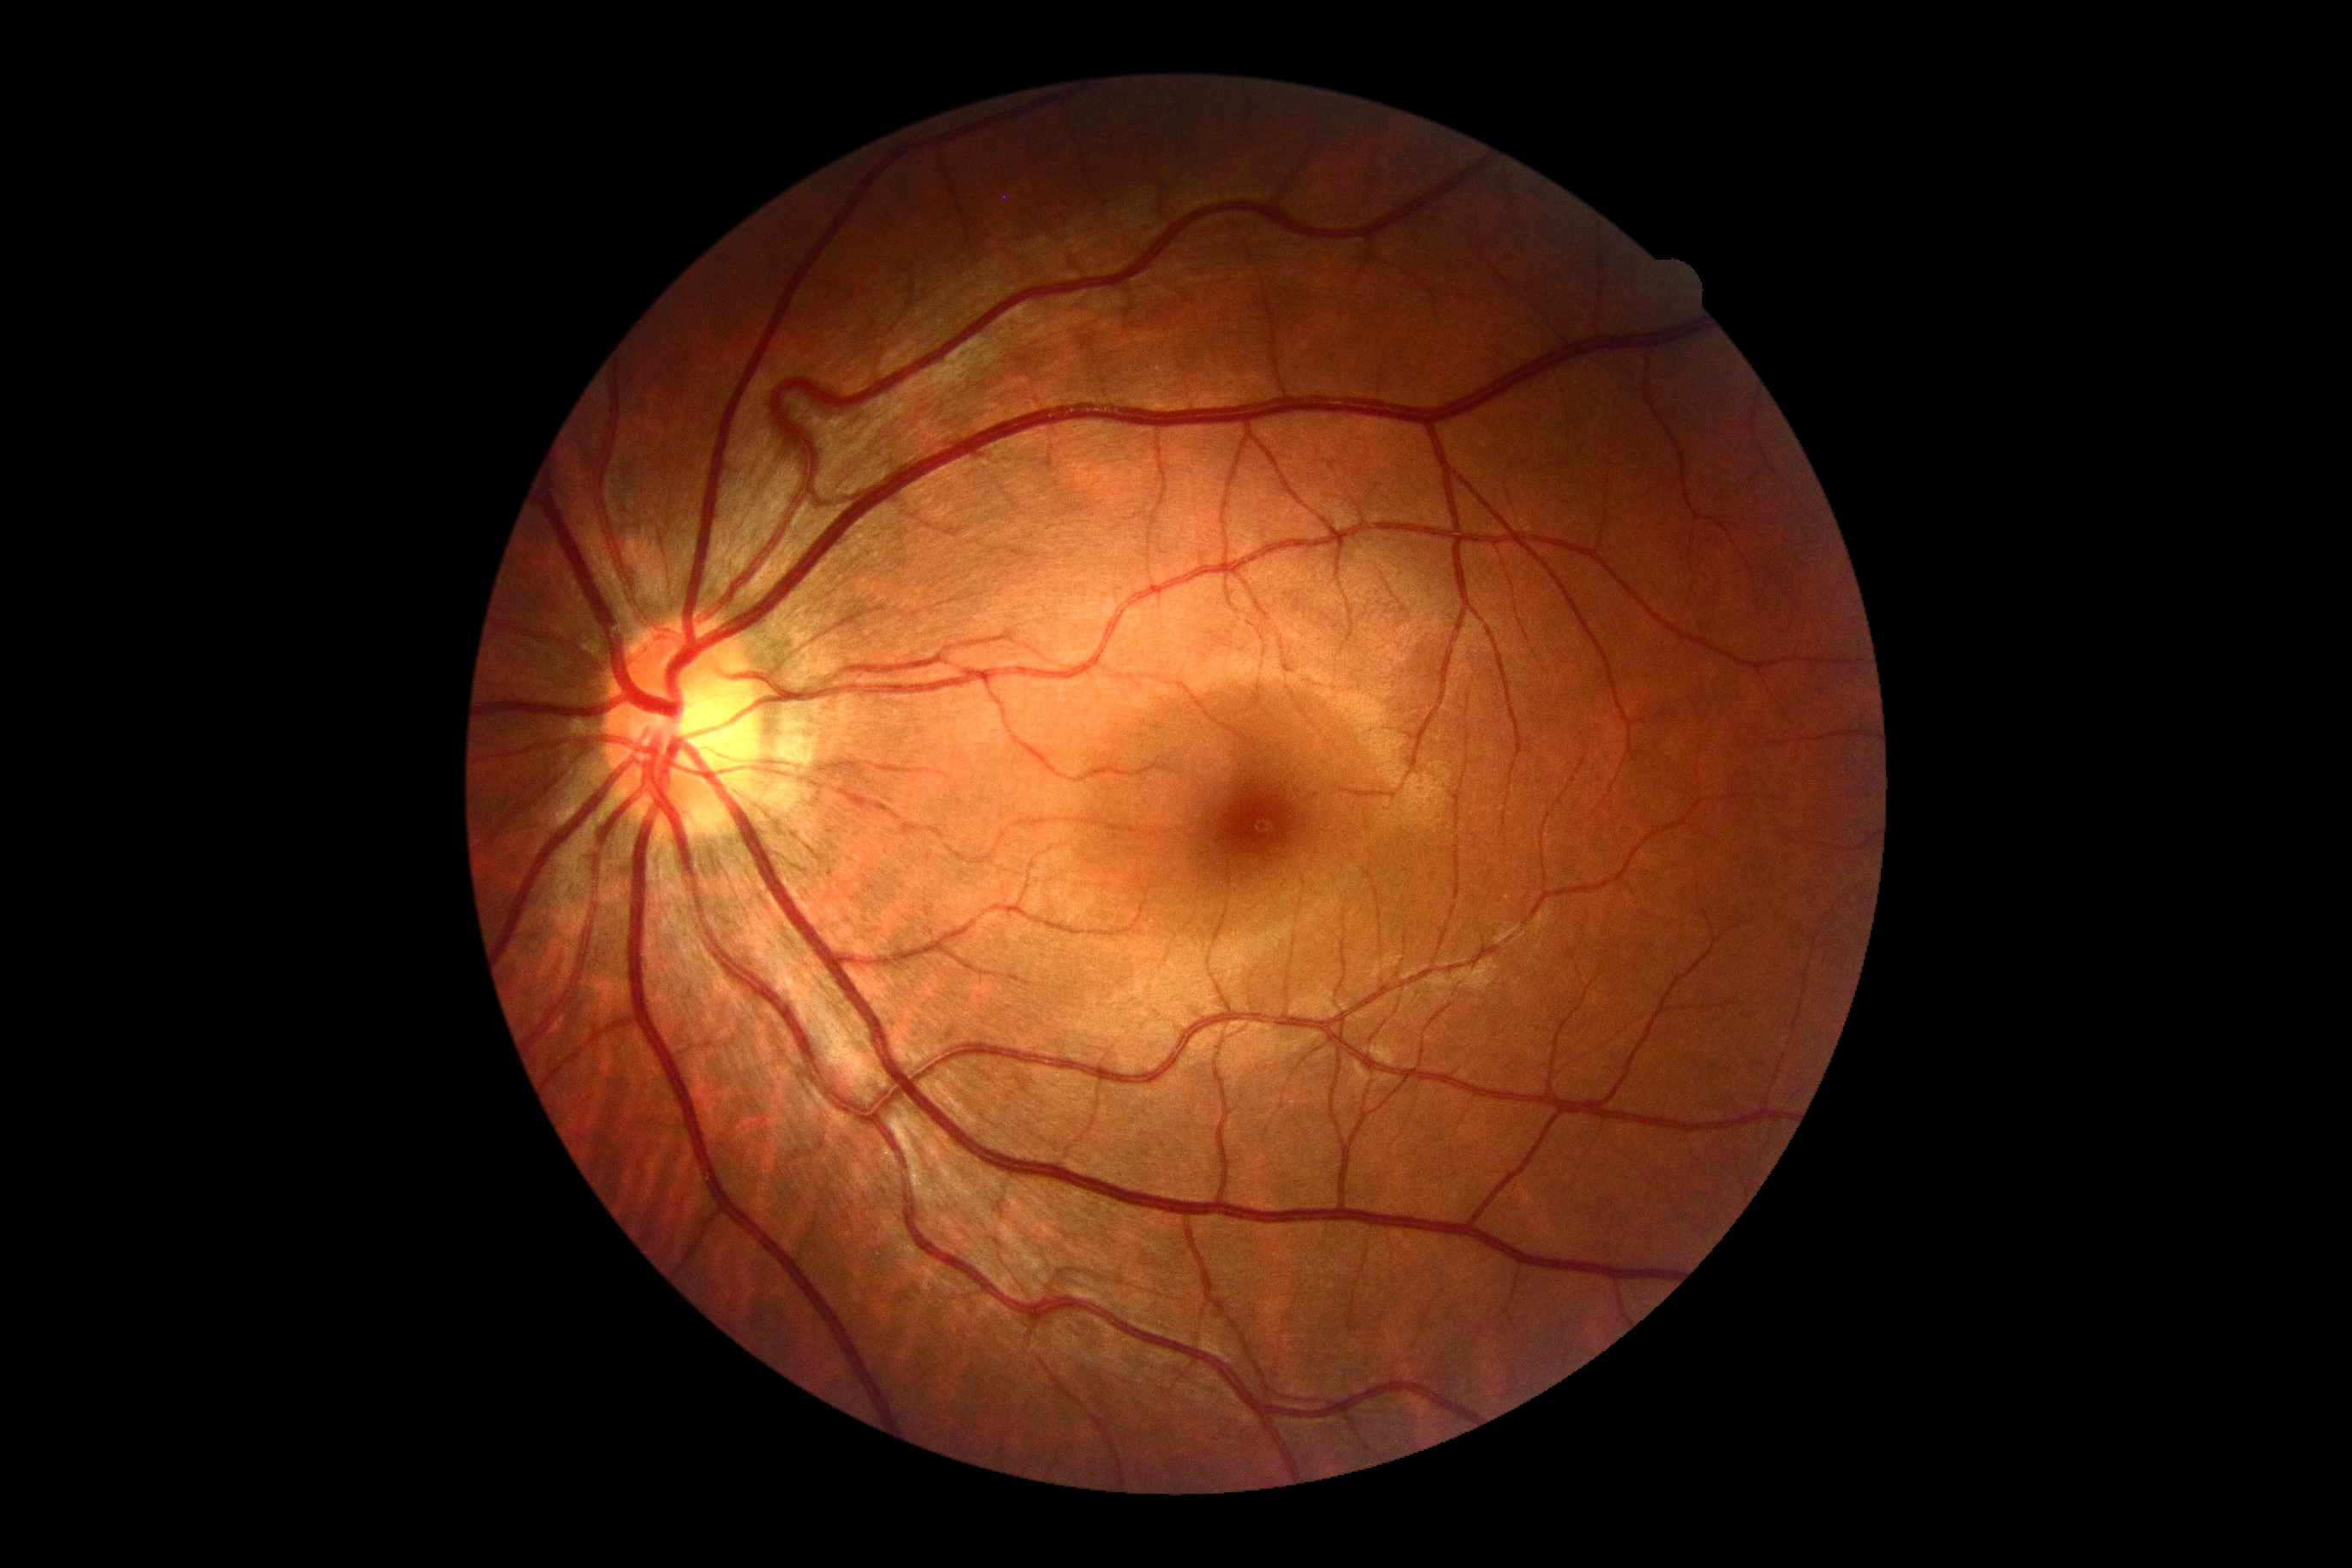
DR = grade 0 (no apparent retinopathy).